Posterior pole photograph: 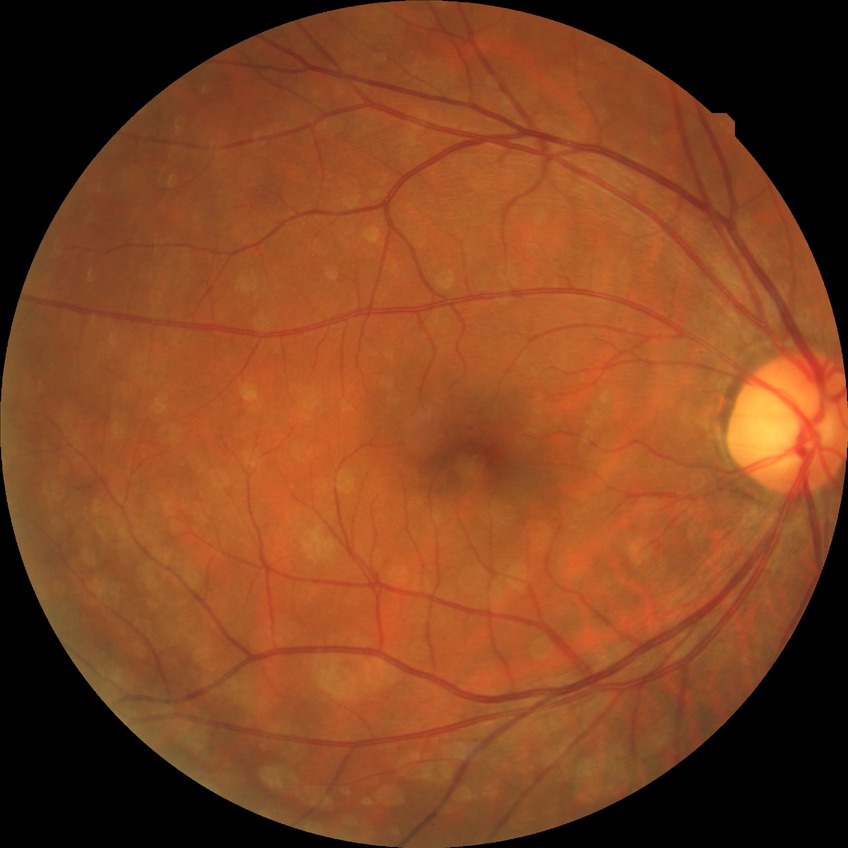

Davis DR grade: SDR.